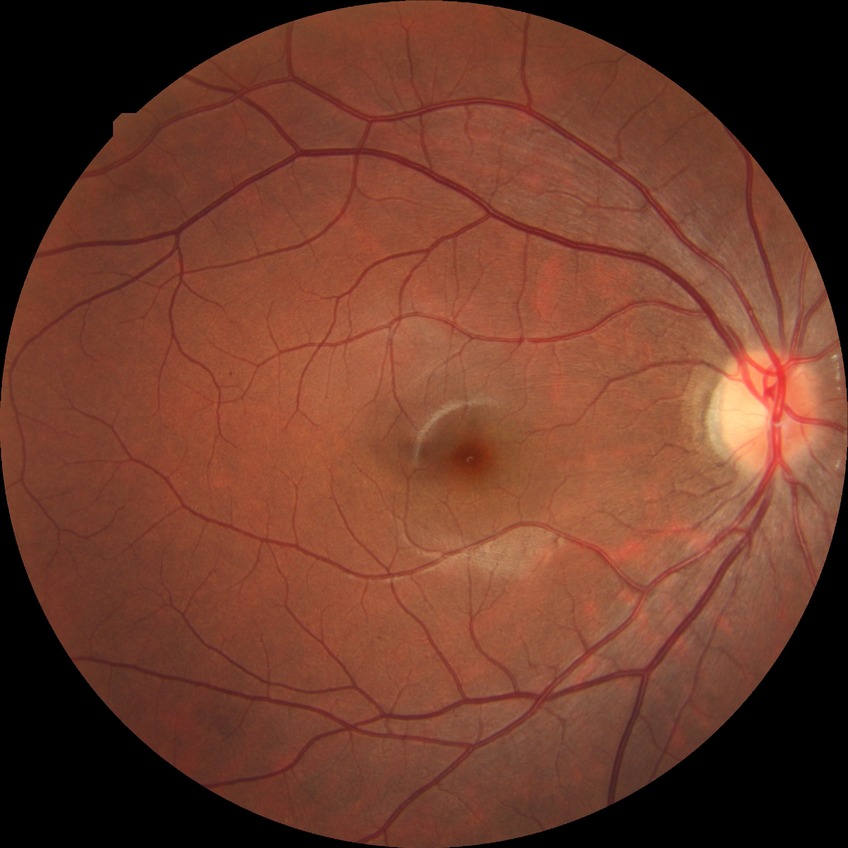

Diabetic retinopathy (DR): SDR (simple diabetic retinopathy).